Graded on the modified Davis scale
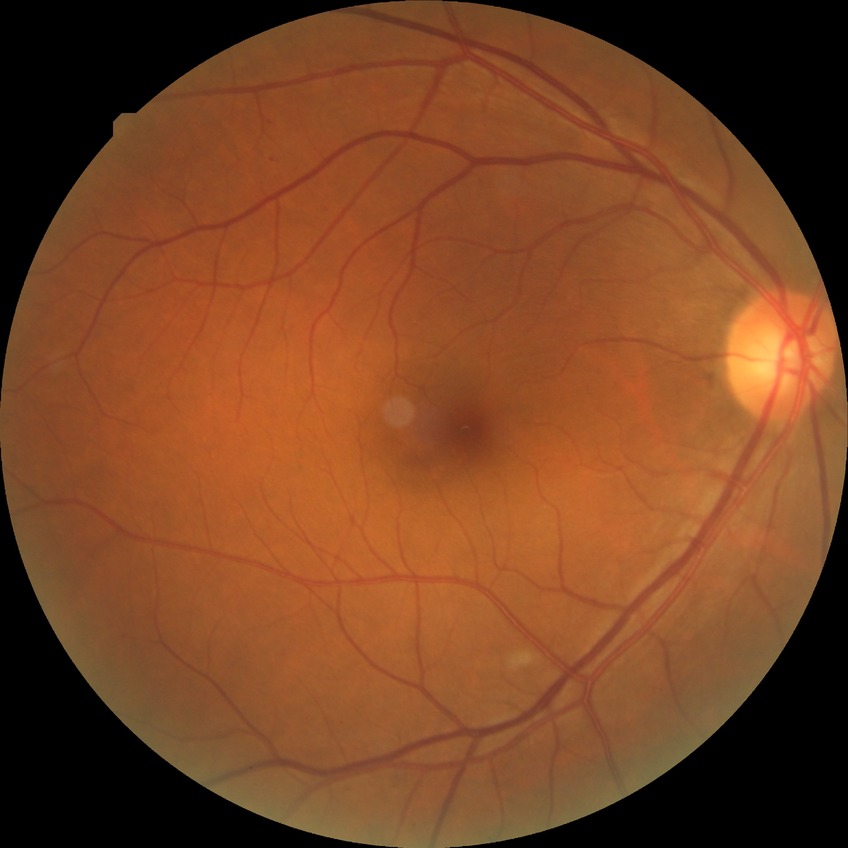 Retinopathy stage: no diabetic retinopathy.